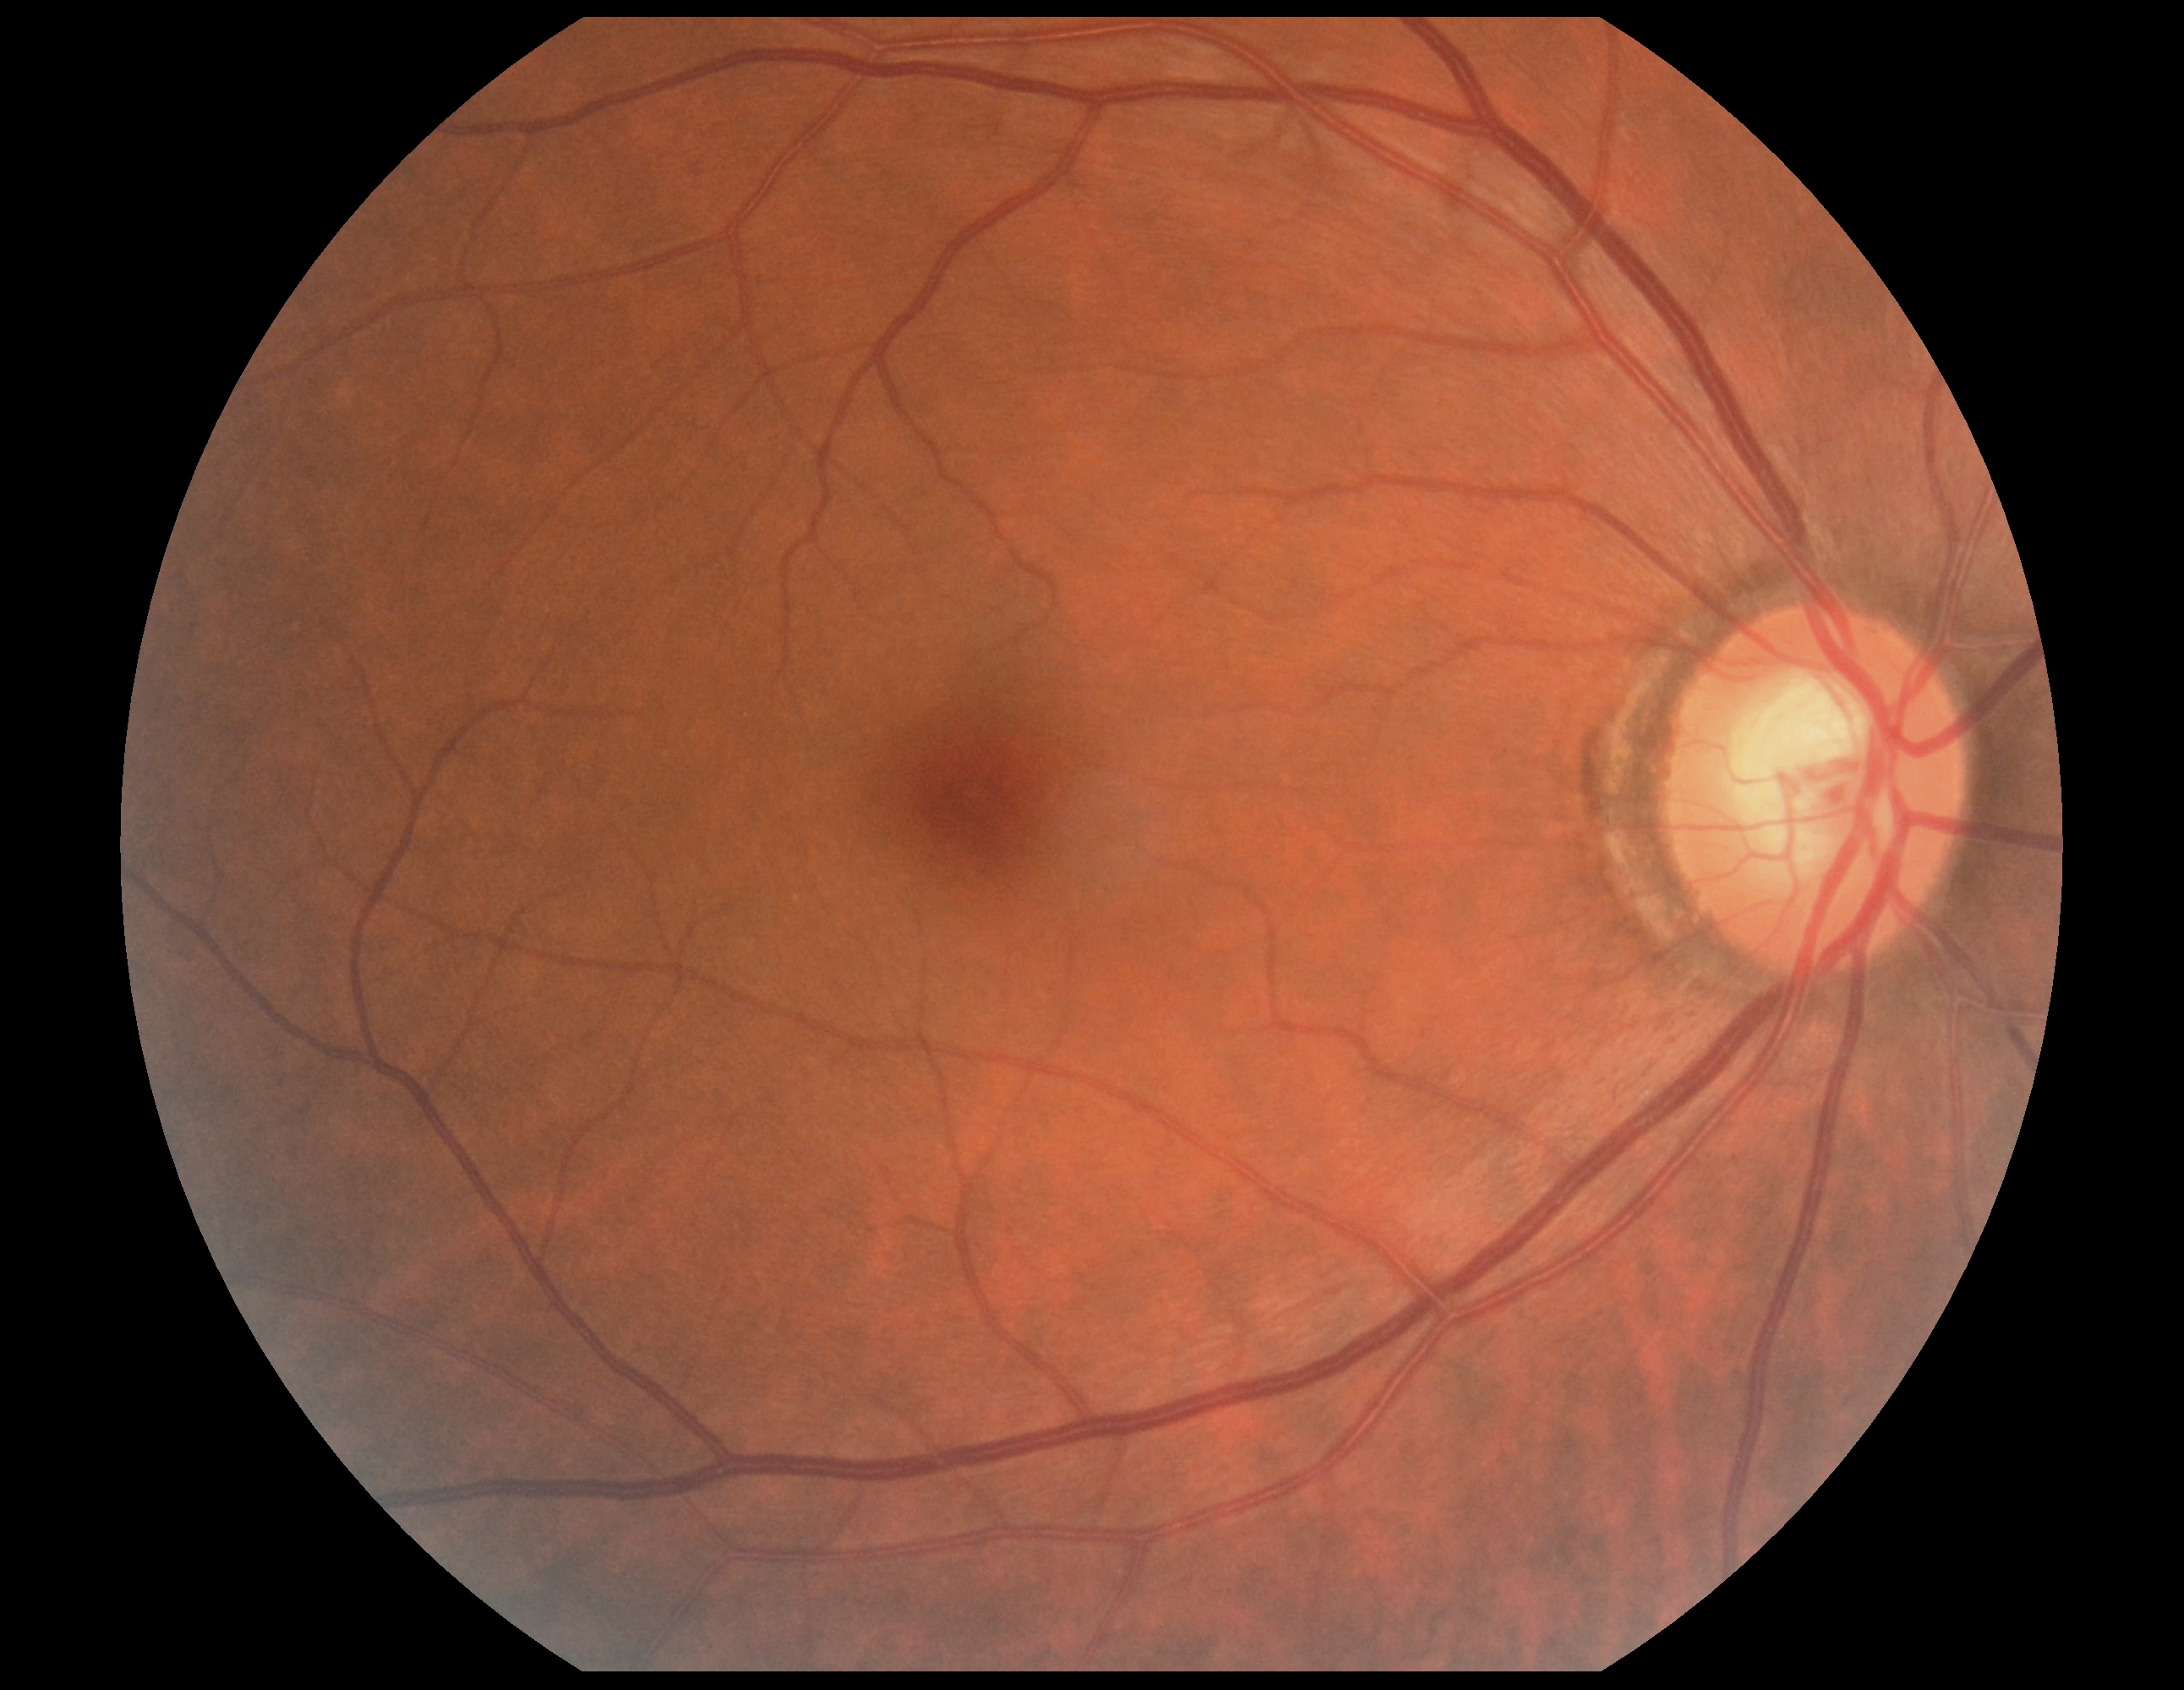 • diabetic retinopathy grade: 0 — no visible signs of diabetic retinopathy